Wide-field fundus photograph of an infant · captured with the Phoenix ICON (100° field of view).
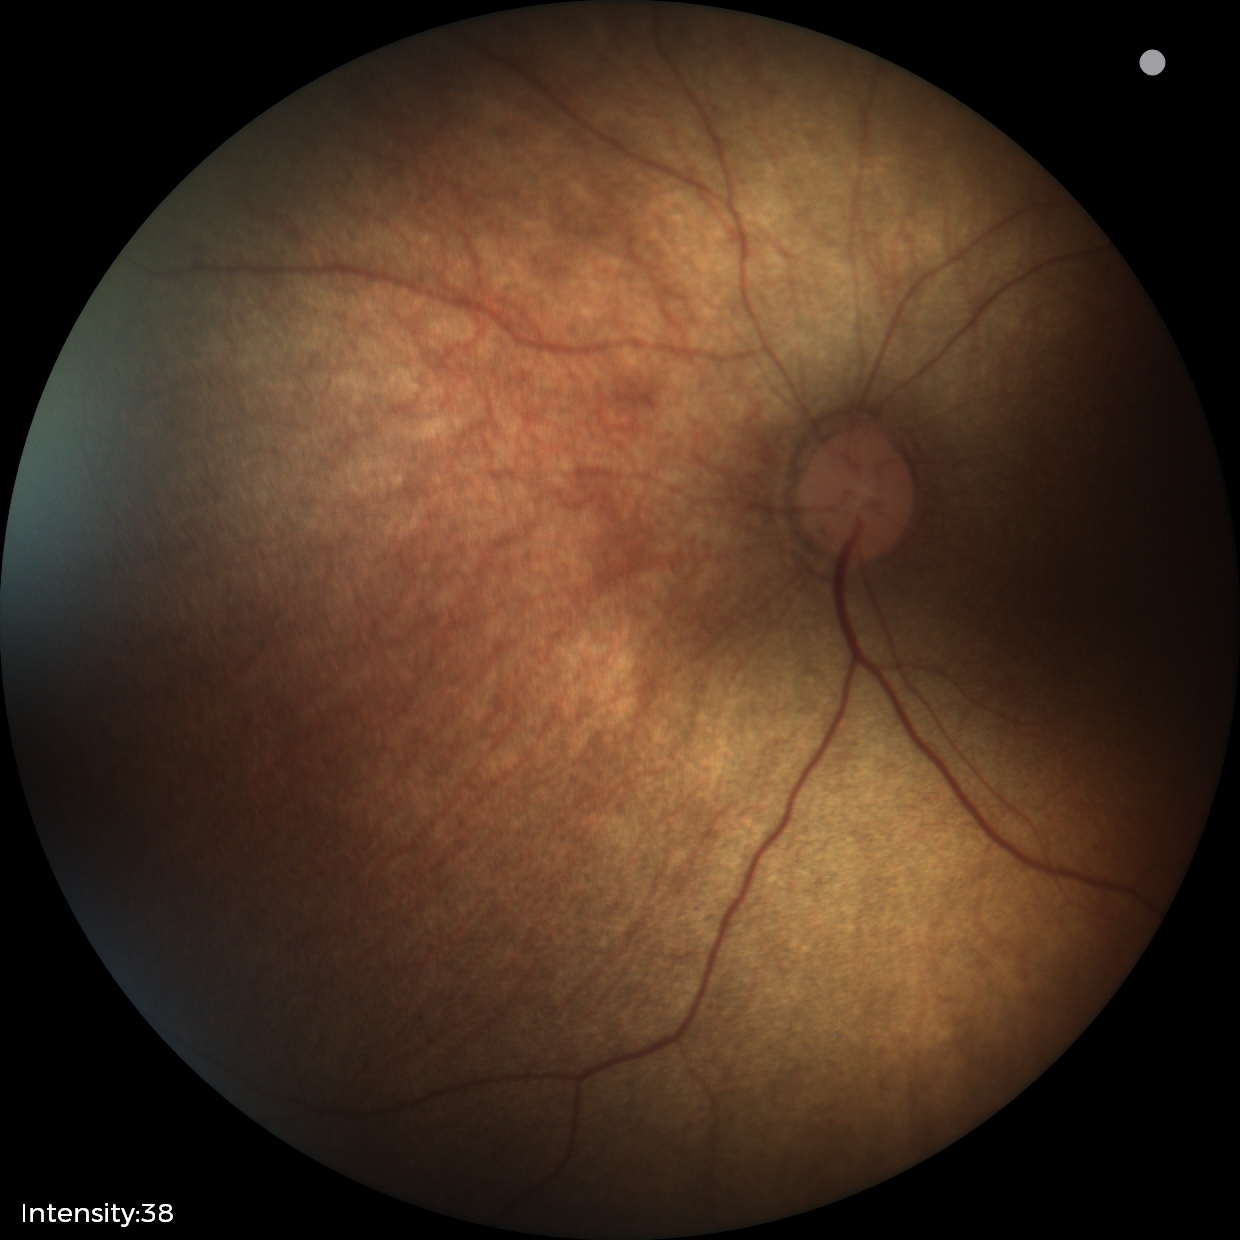

Finding: no pathology identified